45-degree field of view
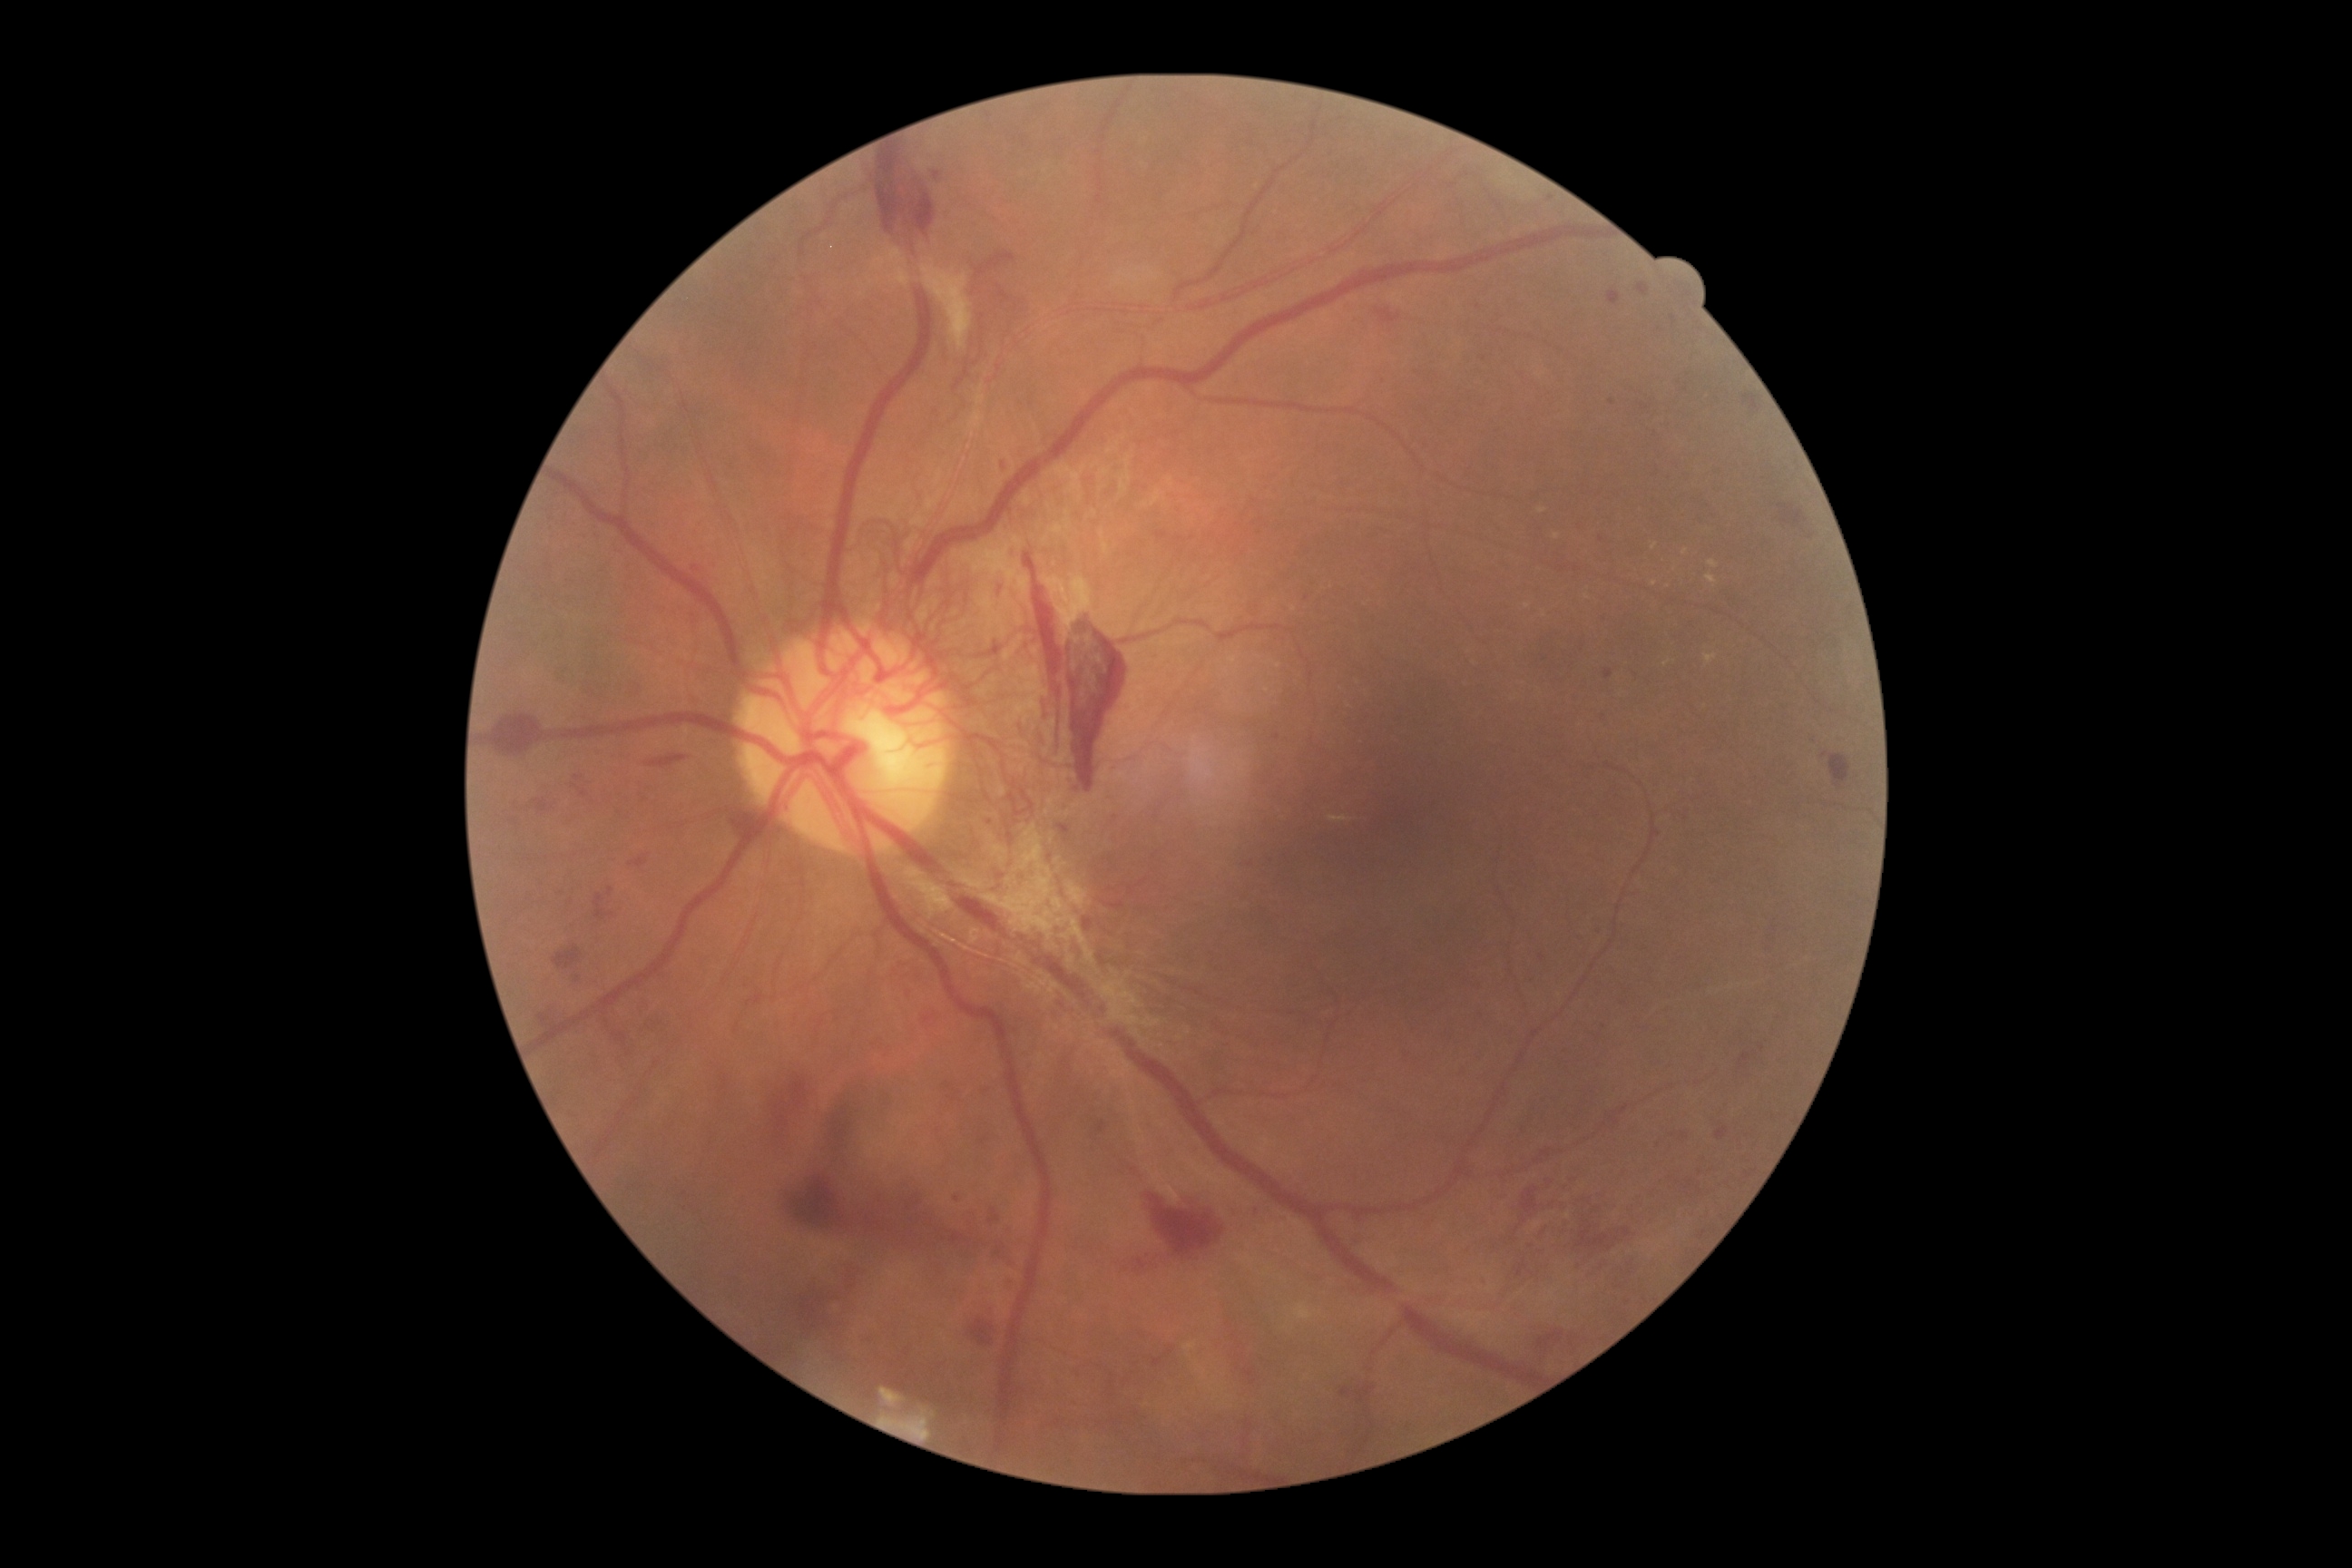
Diabetic retinopathy (DR) is grade 4
Lesions identified (partial list):
hemorrhages (HEs) (continued): [left=988, top=1208, right=1001, bottom=1226], [left=1511, top=1217, right=1527, bottom=1244], [left=1132, top=1259, right=1148, bottom=1277], [left=485, top=712, right=545, bottom=756], [left=787, top=1177, right=850, bottom=1231], [left=1774, top=502, right=1808, bottom=534], [left=574, top=776, right=585, bottom=783], [left=798, top=1293, right=841, bottom=1337], [left=538, top=1010, right=564, bottom=1030], [left=905, top=1193, right=923, bottom=1213], [left=1084, top=917, right=1095, bottom=932], [left=553, top=945, right=583, bottom=972], [left=594, top=887, right=616, bottom=921], [left=872, top=148, right=936, bottom=239], [left=629, top=854, right=651, bottom=868]
HEs (small, approximate centers) near x=1601 y=1267, x=934 y=1246, x=1531 y=1247, x=1543 y=1234
microaneurysms (MAs) (continued): [left=923, top=1015, right=936, bottom=1026], [left=1680, top=1132, right=1690, bottom=1142], [left=1057, top=825, right=1072, bottom=843], [left=1112, top=816, right=1119, bottom=825], [left=1003, top=462, right=1006, bottom=471], [left=1671, top=317, right=1678, bottom=329], [left=1603, top=669, right=1612, bottom=681], [left=1095, top=1121, right=1108, bottom=1135], [left=1716, top=1124, right=1730, bottom=1142]
MAs (small, approximate centers) near x=1276 y=737, x=1550 y=199, x=908 y=995, x=1582 y=648, x=1612 y=403